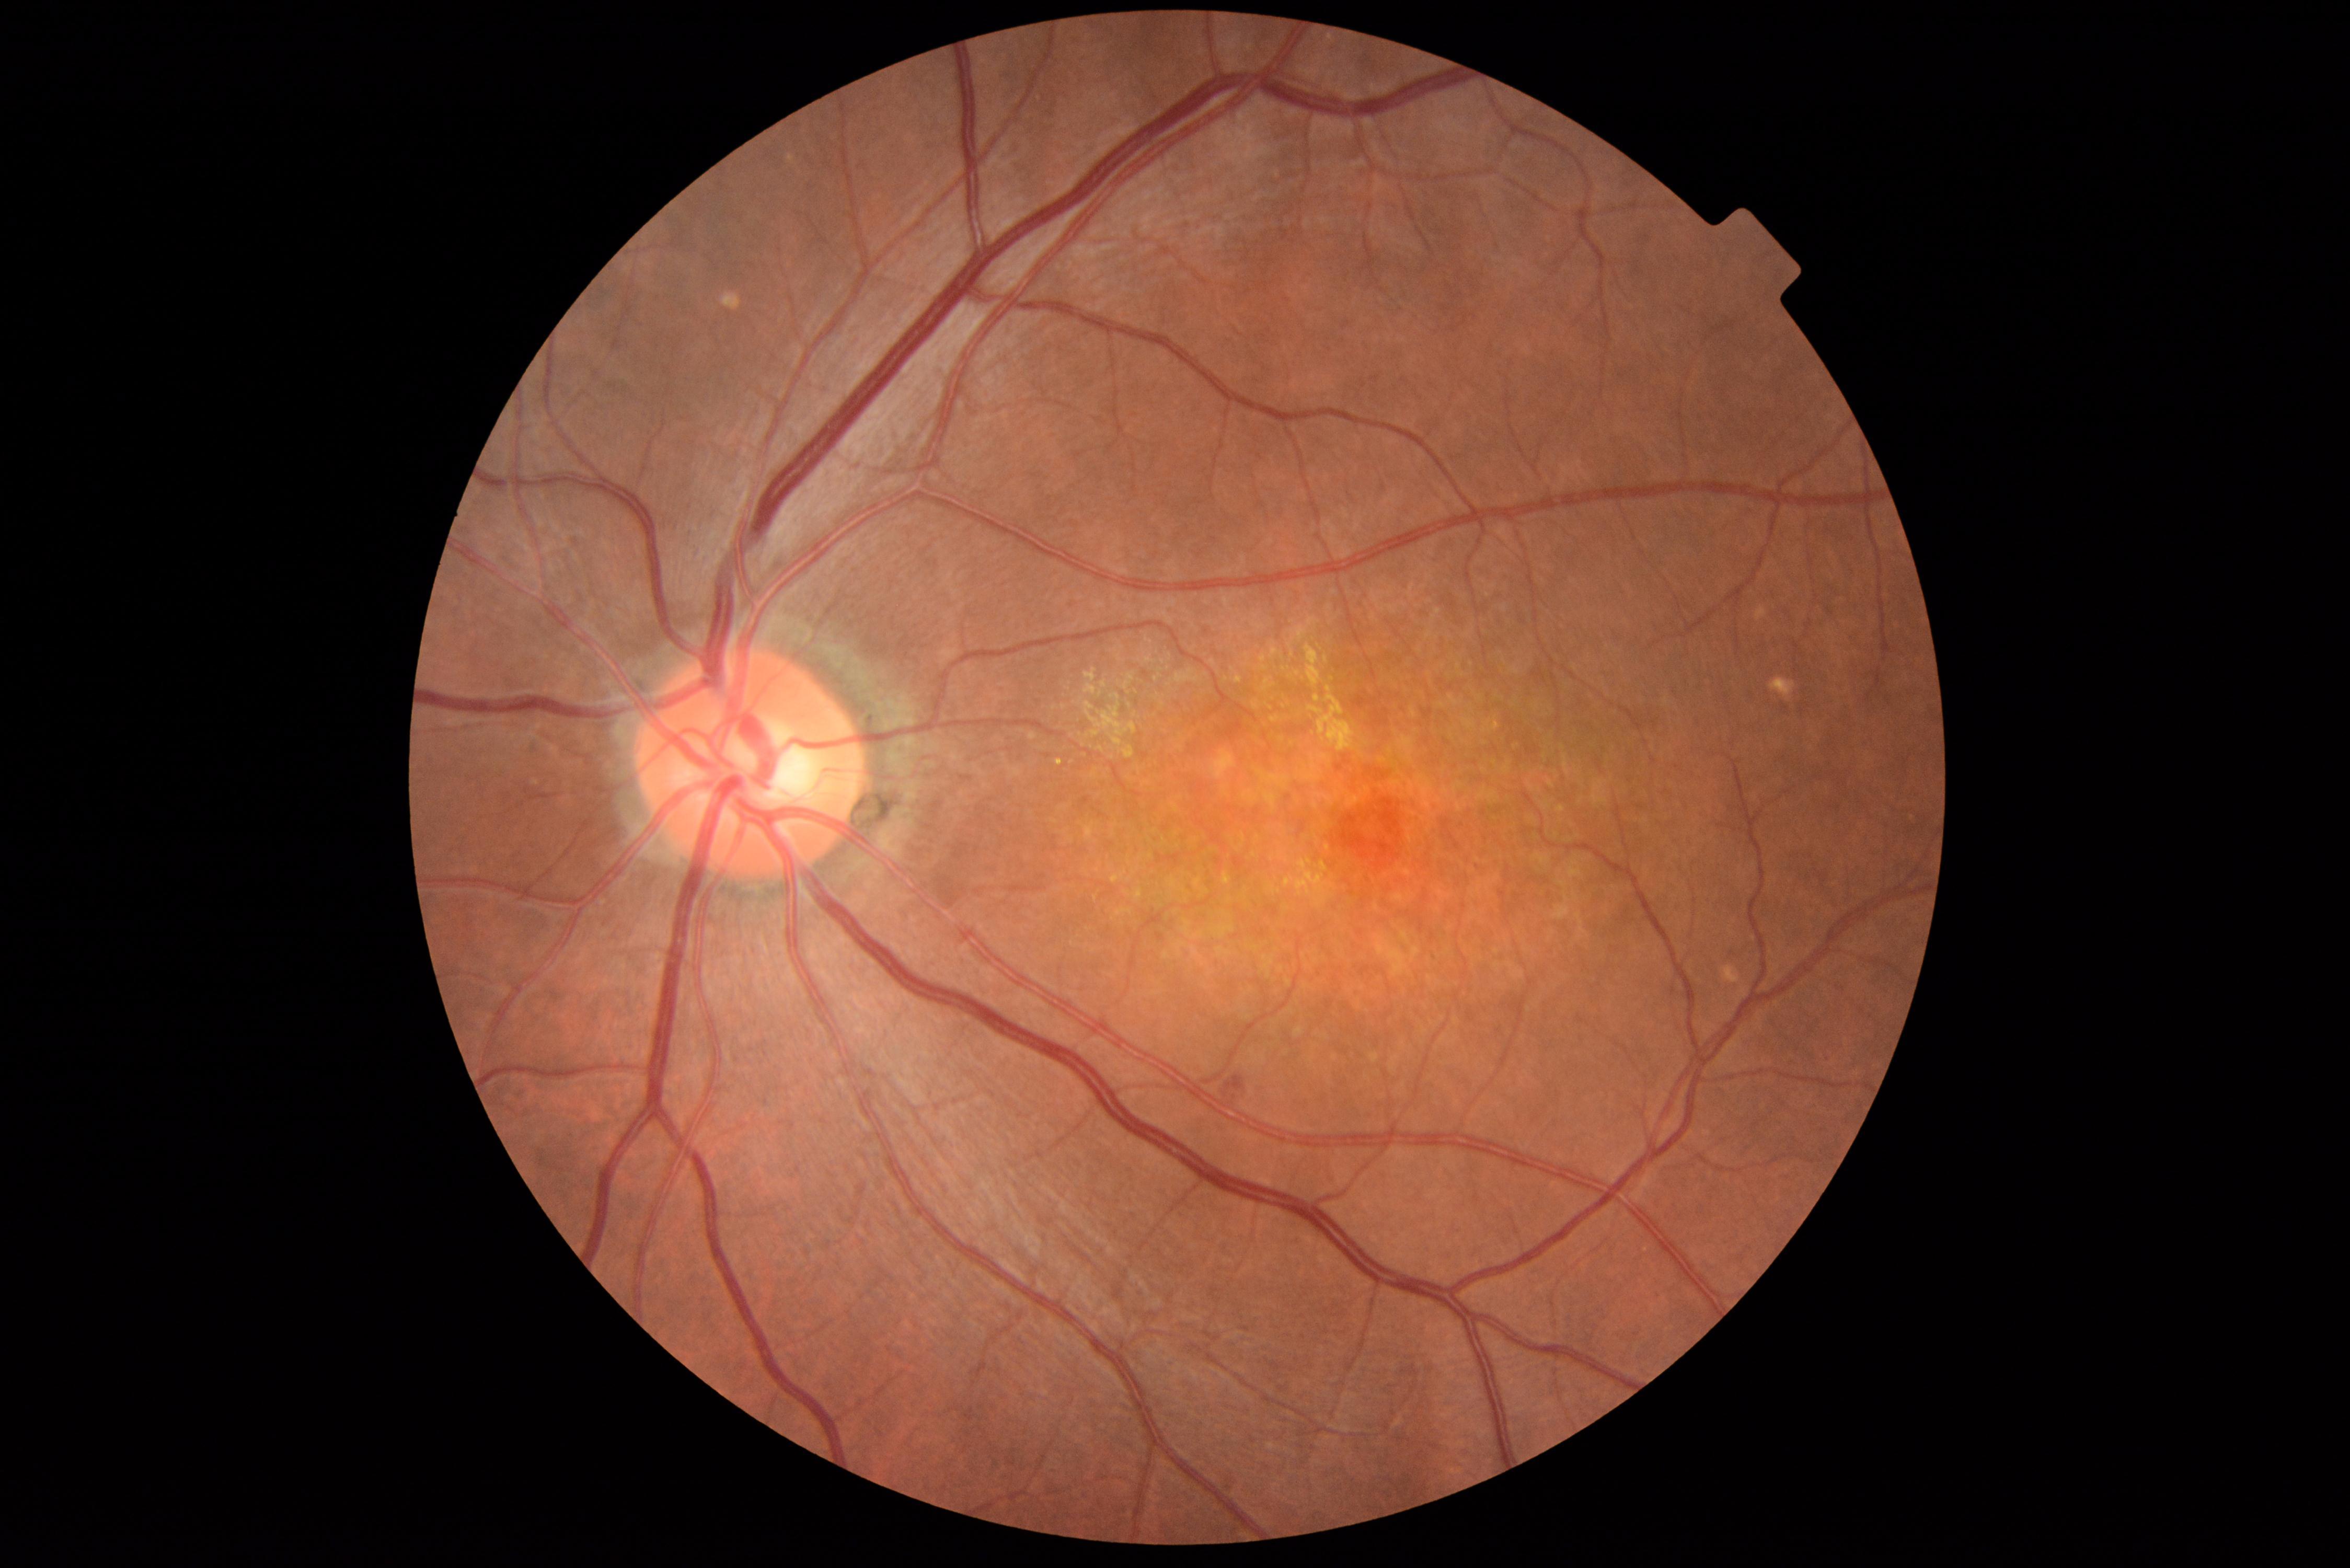
DR stage: 2 — more than just microaneurysms but less than severe NPDR.